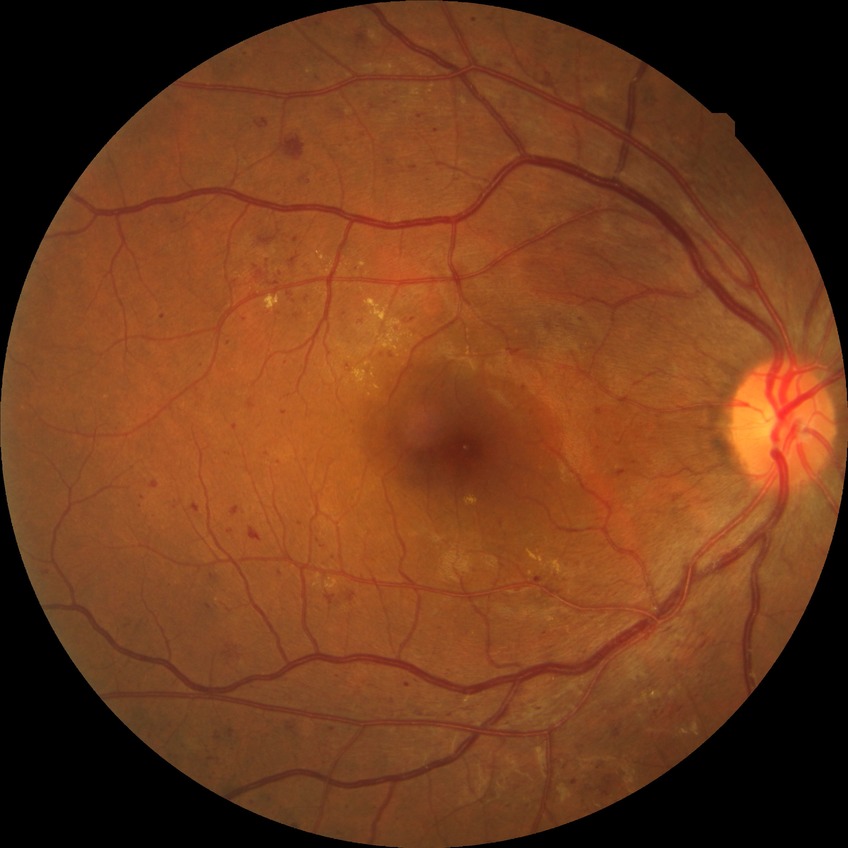
DR severity: SDR.